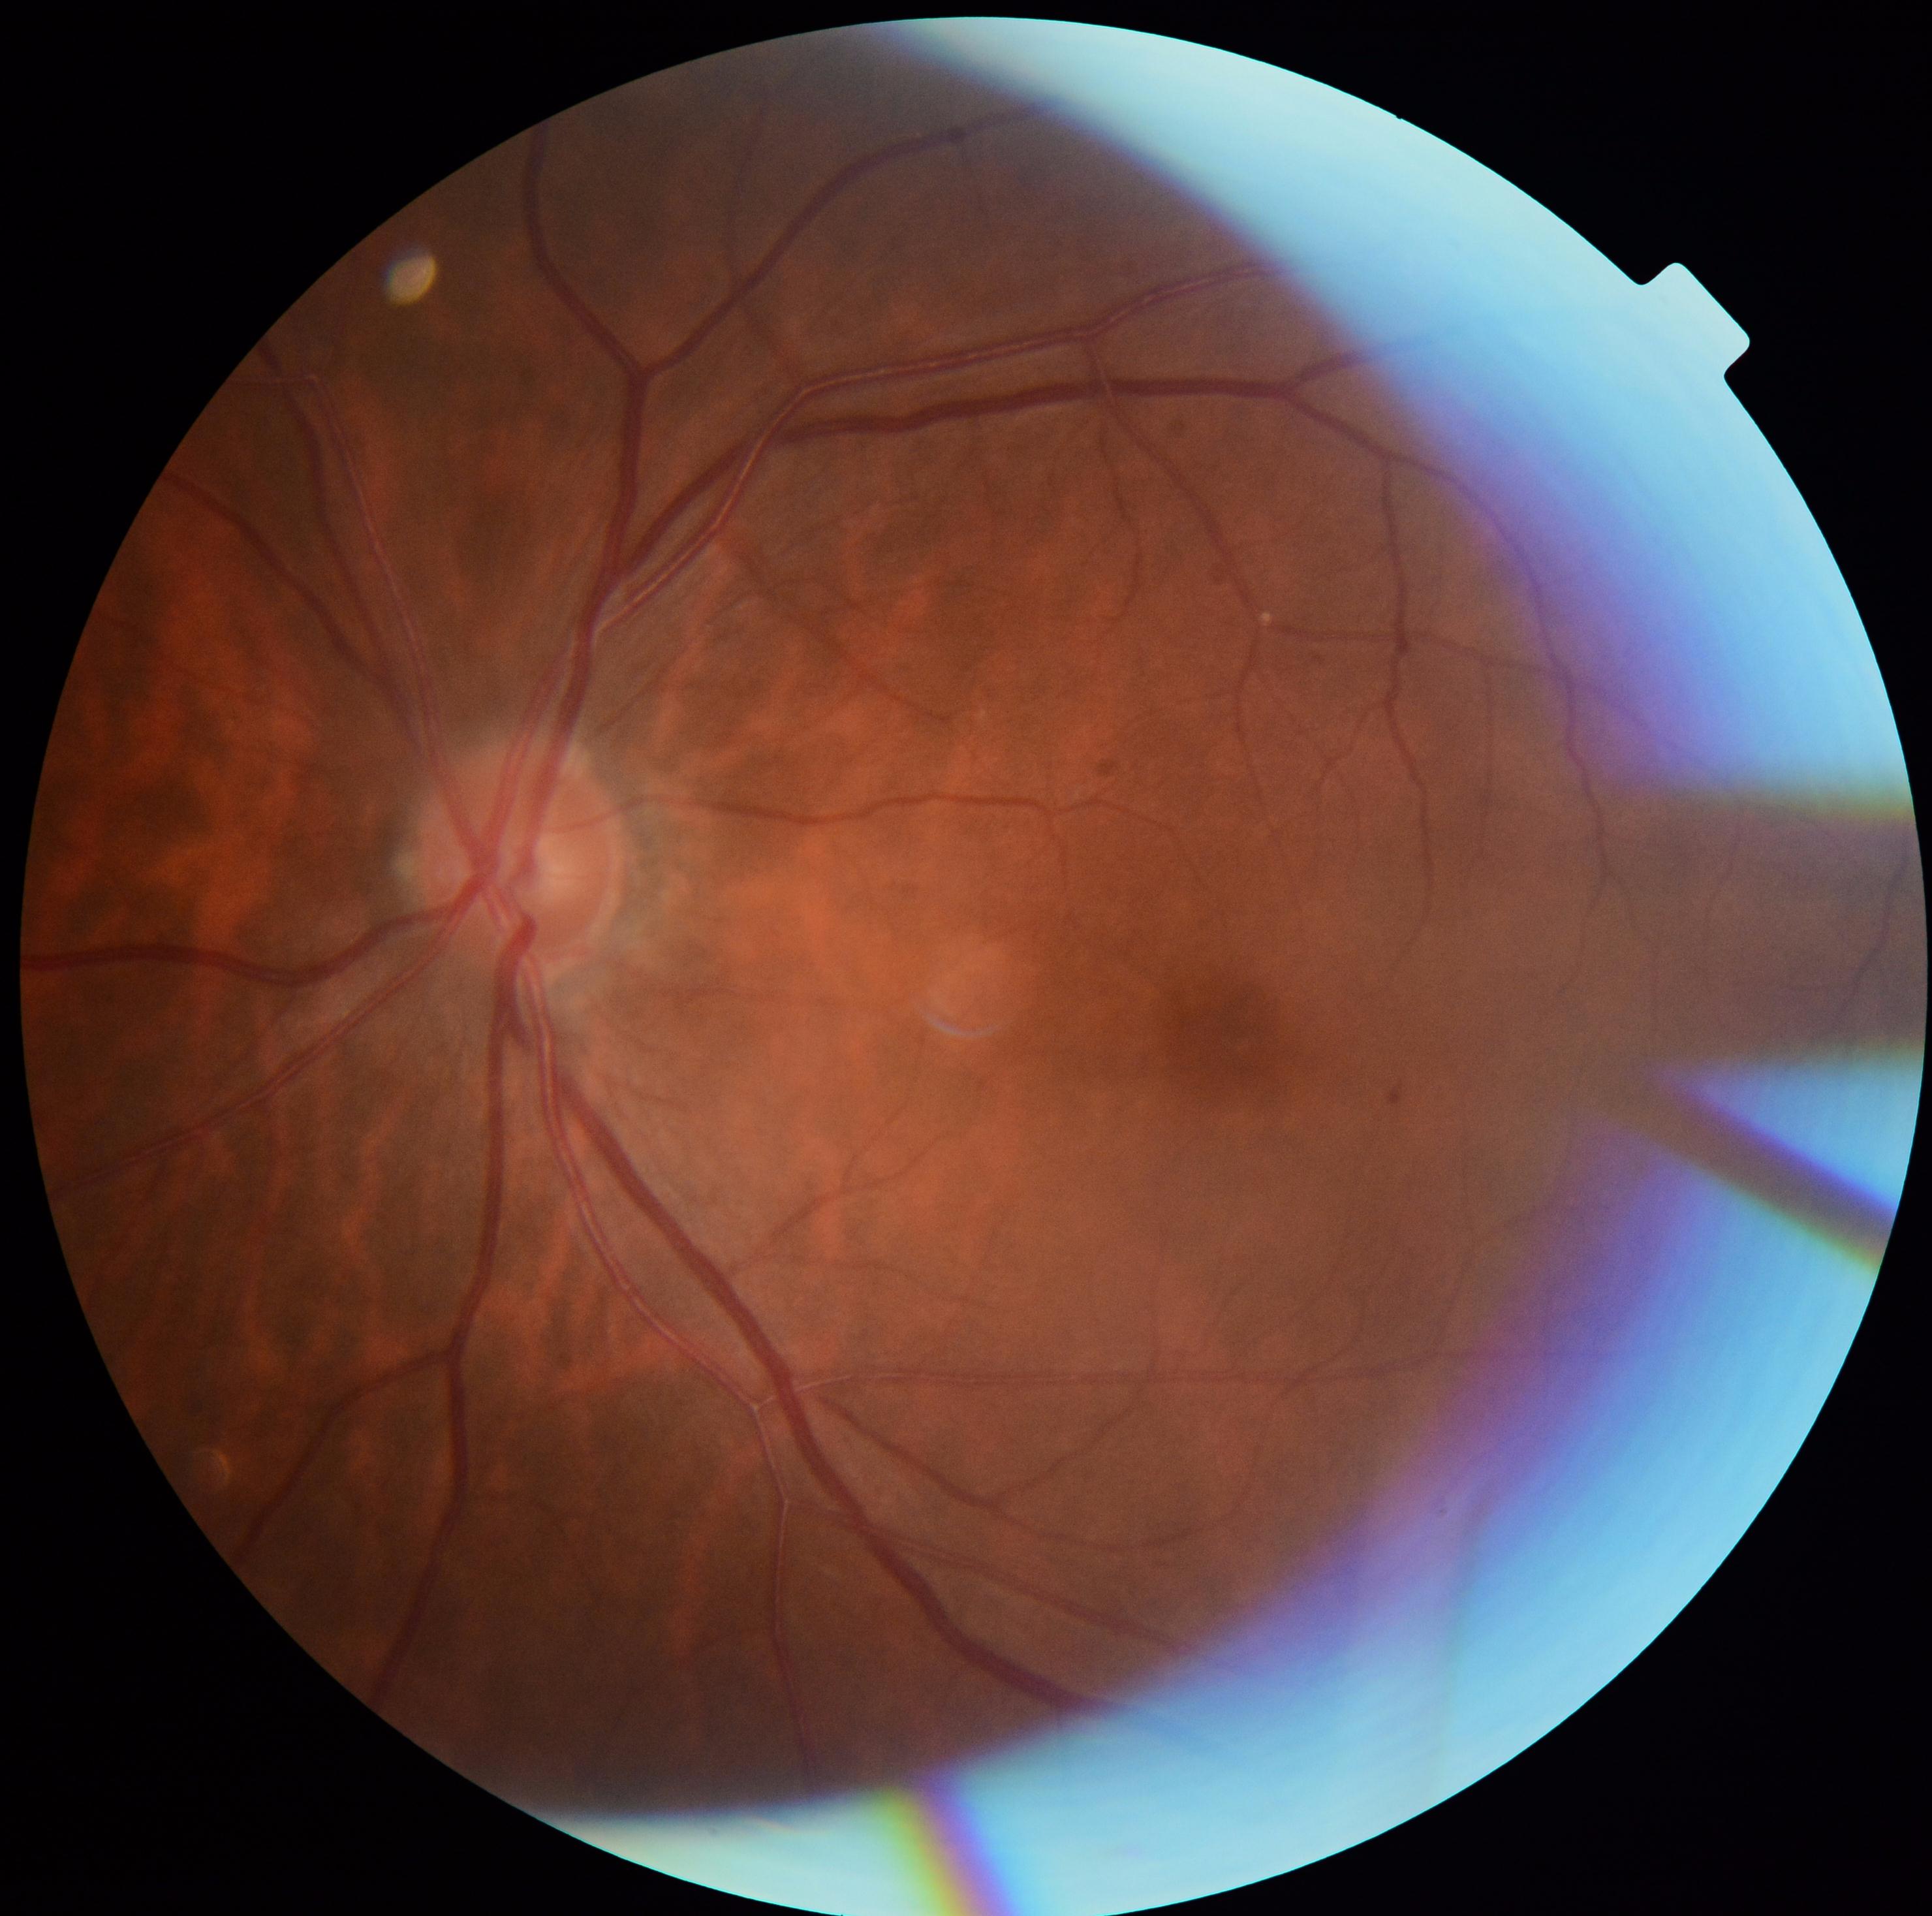

DR is grade 1. Disease class: non-proliferative diabetic retinopathy.